Image size 2089x1764:
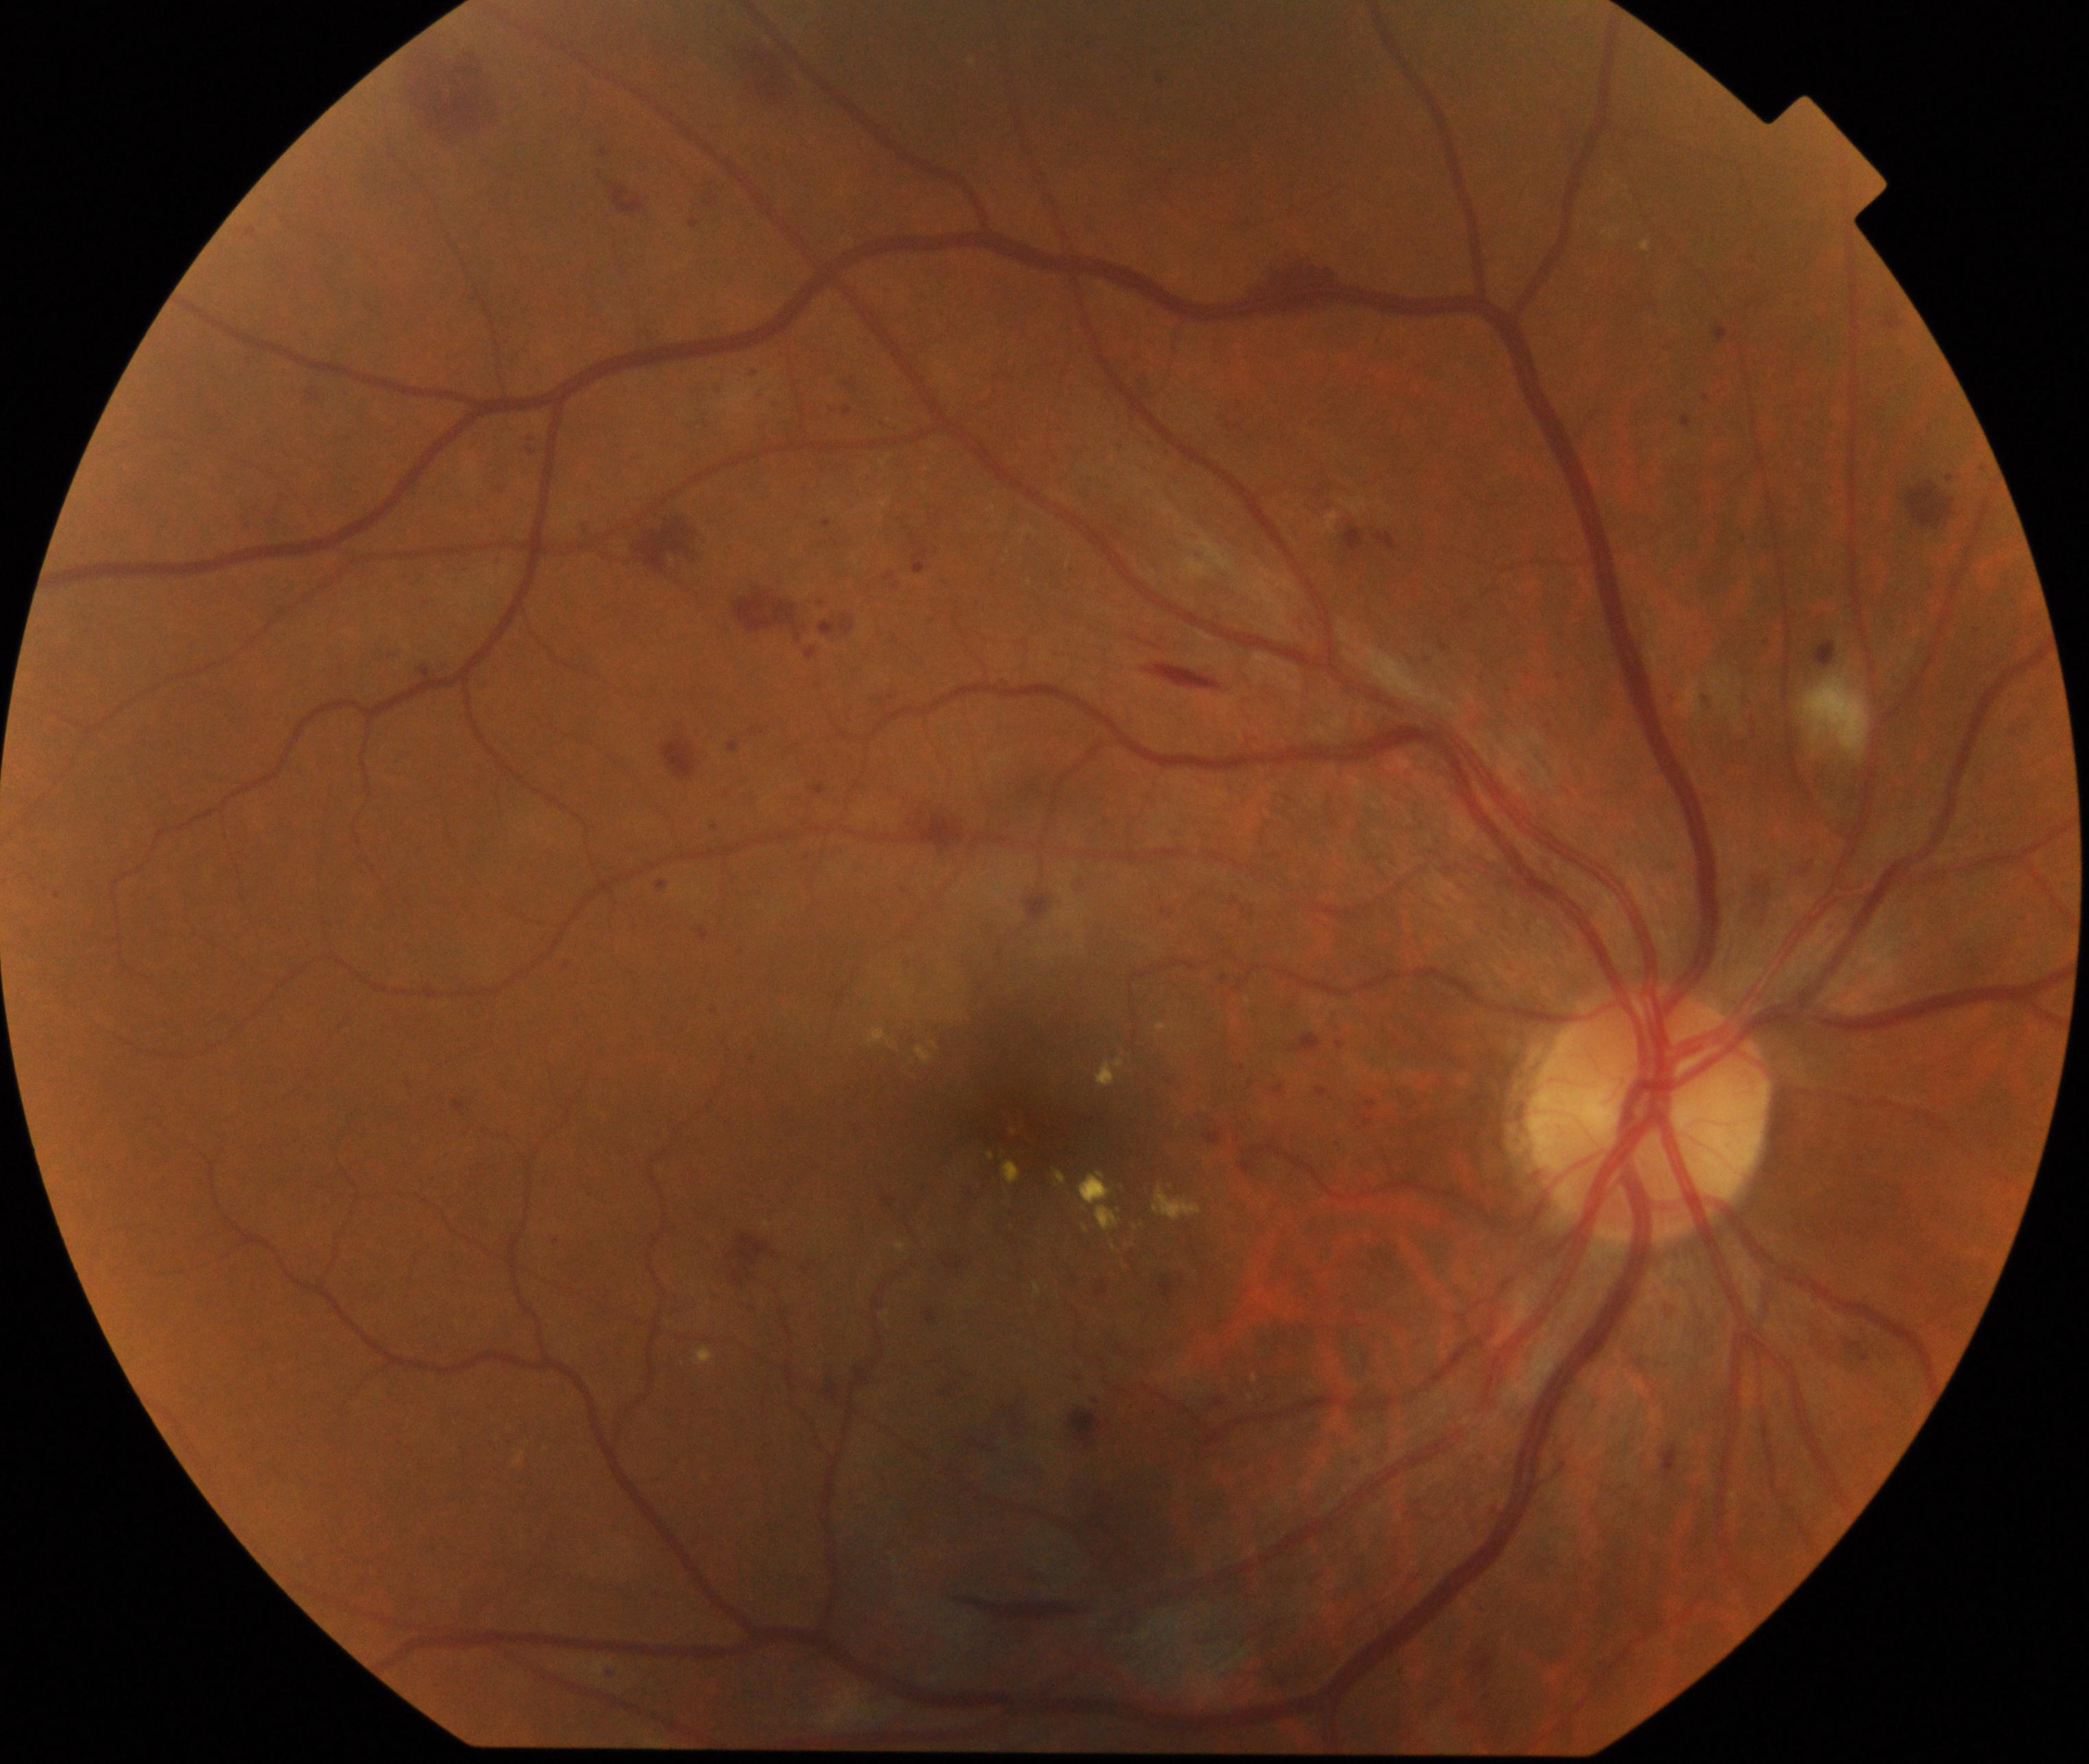

This fundus photograph shows moderate non-proliferative diabetic retinopathy. Defined by microaneurysms with dot and blot hemorrhages or hard exudates, less than severe non-proliferative diabetic retinopathy, and/or with diabetic macular edema.